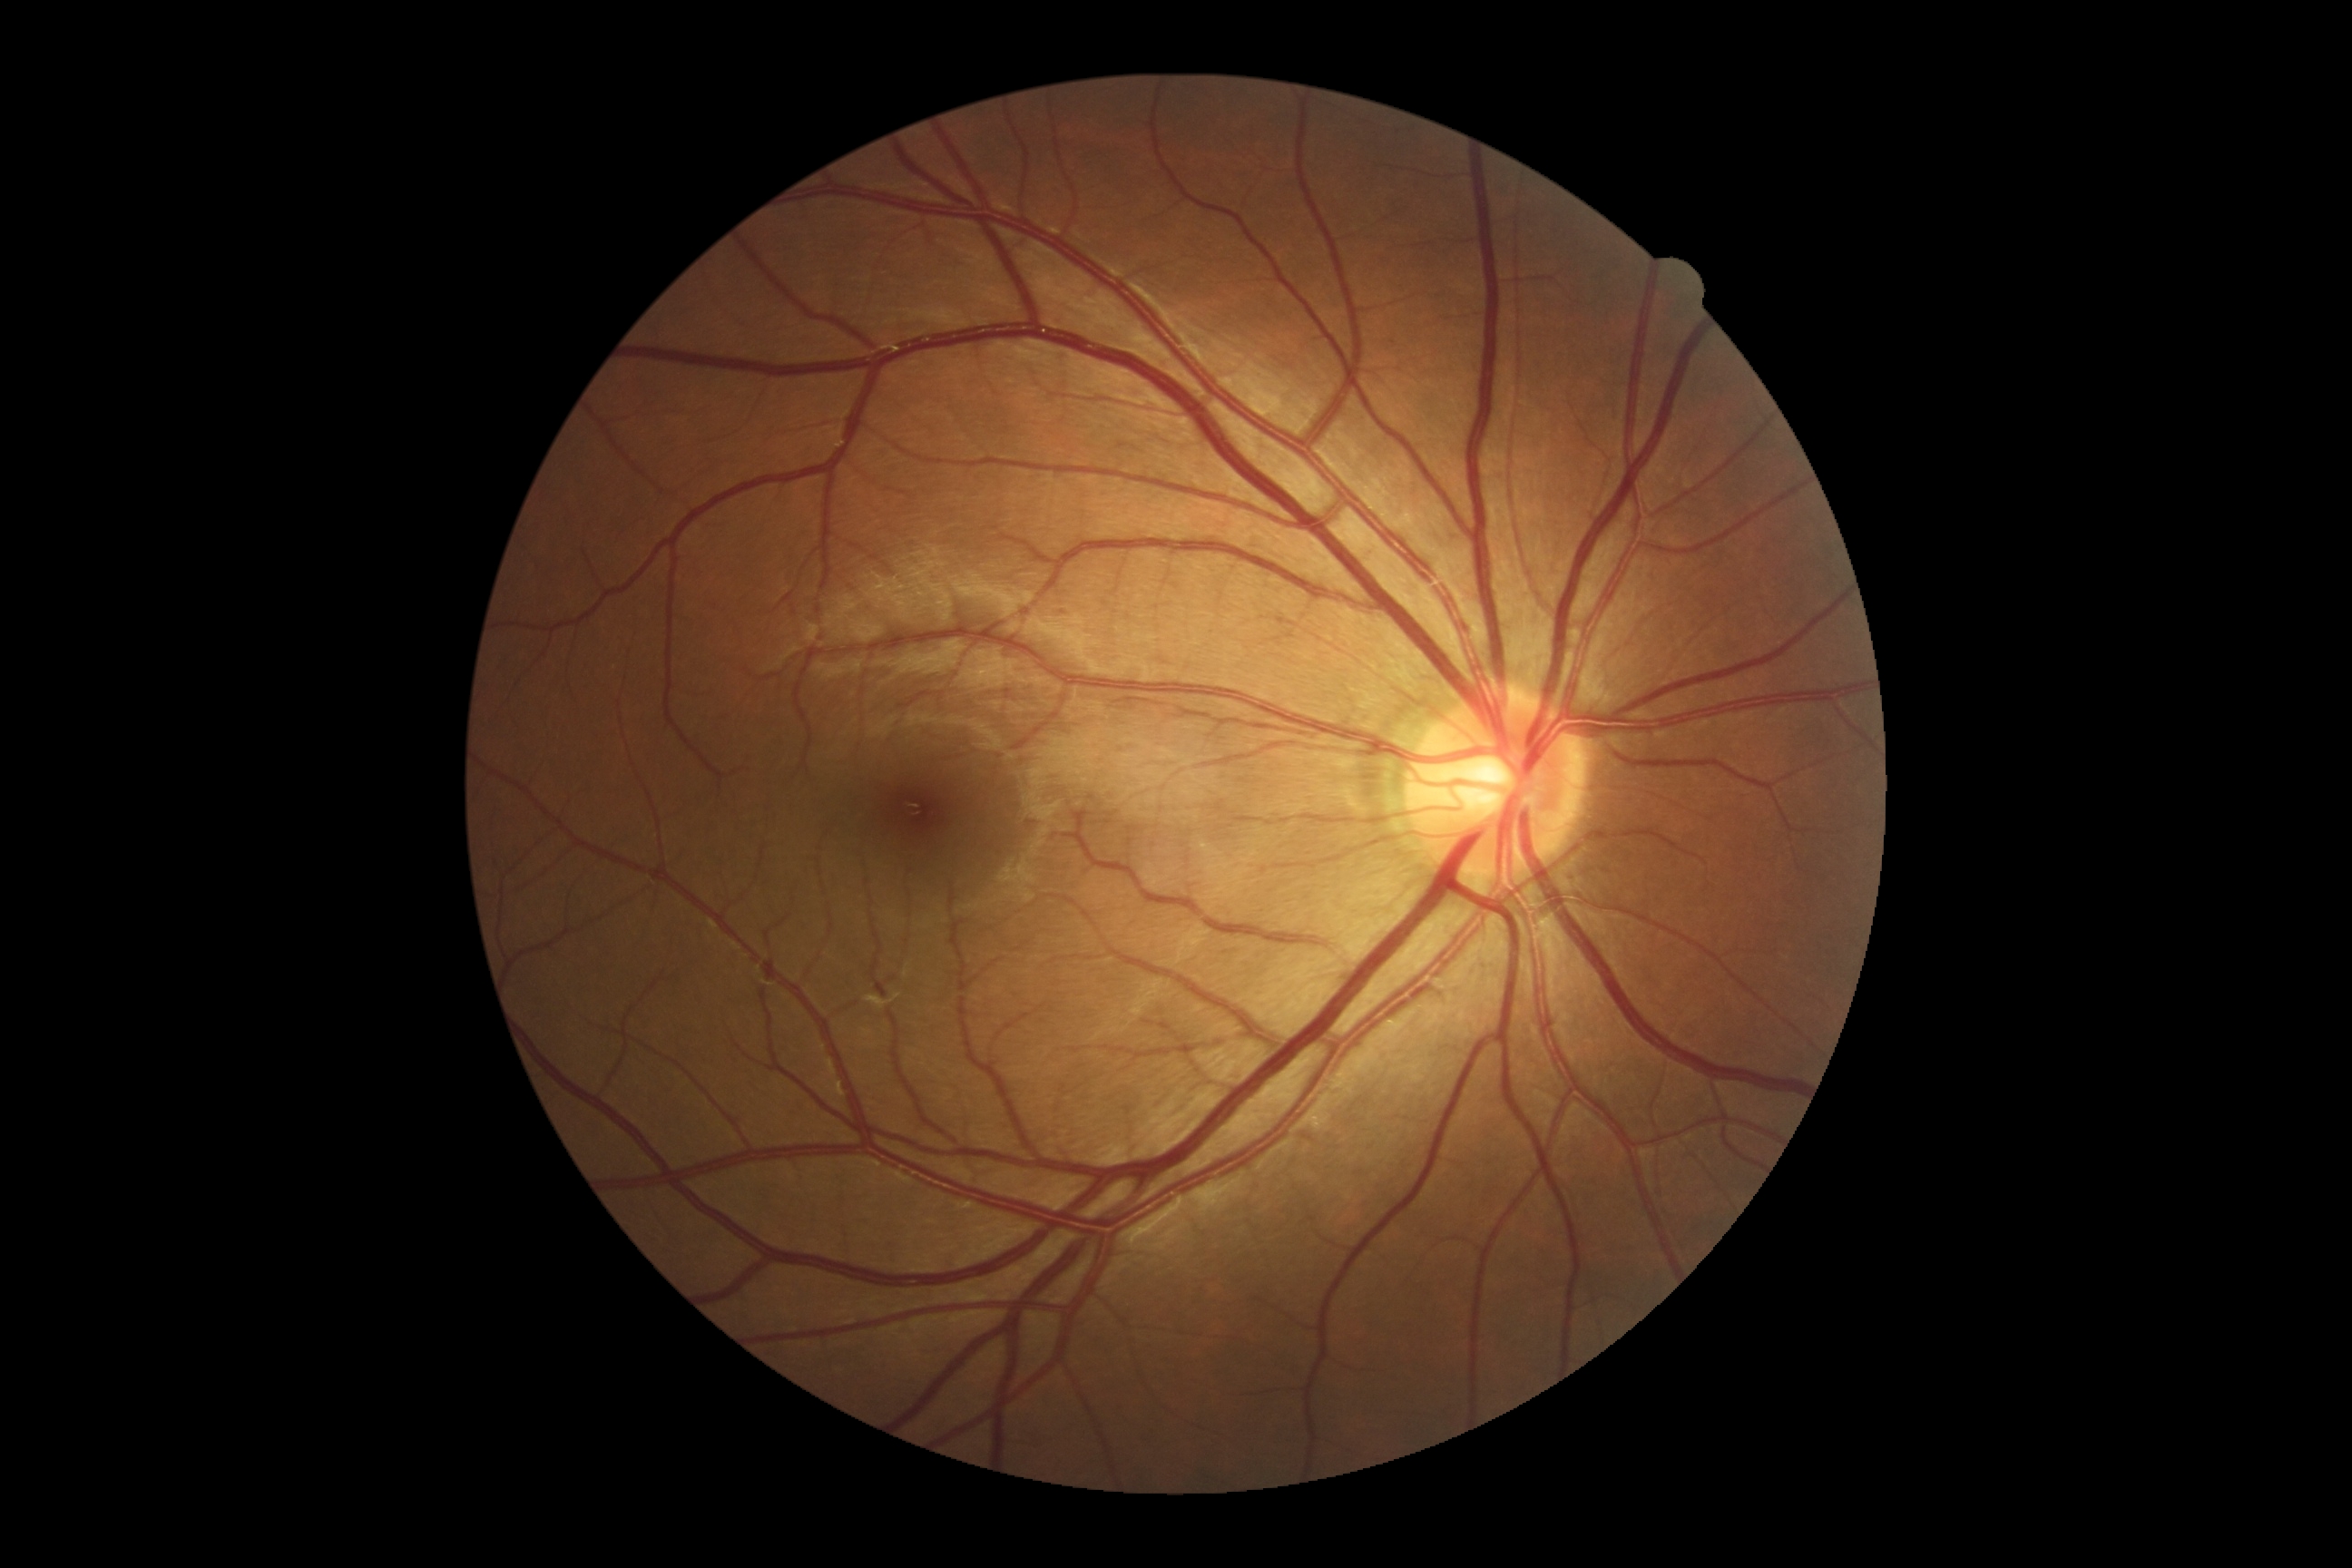 {
  "dr_grade": "0 (no apparent retinopathy)"
}